Diabetic retinopathy graded by the modified Davis classification · without pupil dilation — 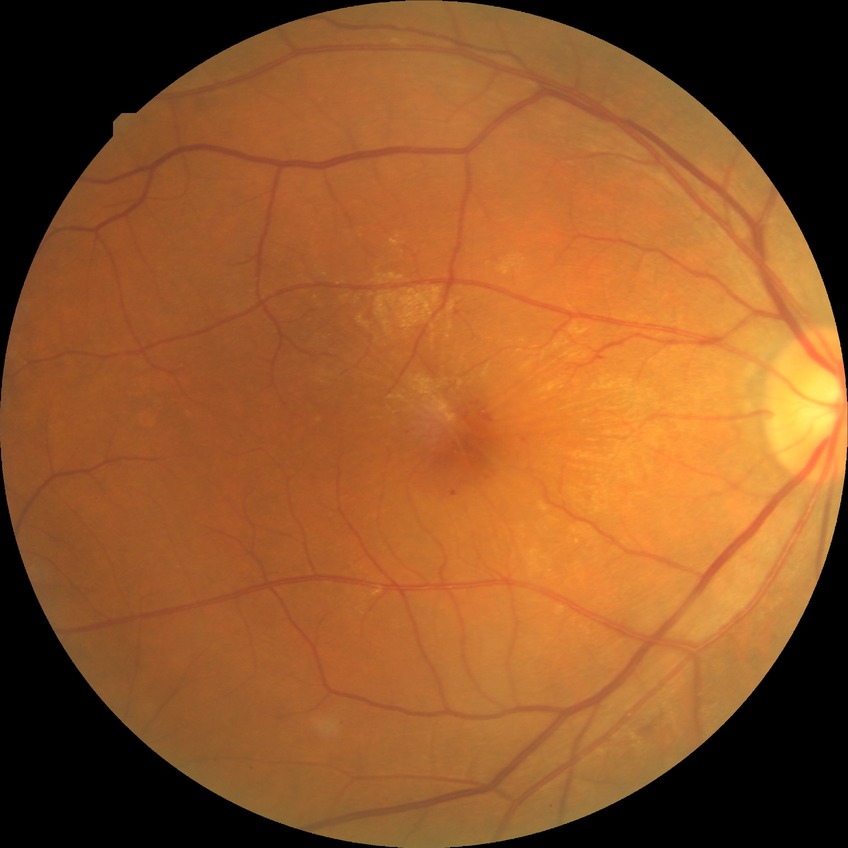
Diabetic retinopathy (DR) is SDR (simple diabetic retinopathy).